Camera: Phoenix ICON (100° FOV); 1240x1240px; wide-field fundus photograph of an infant
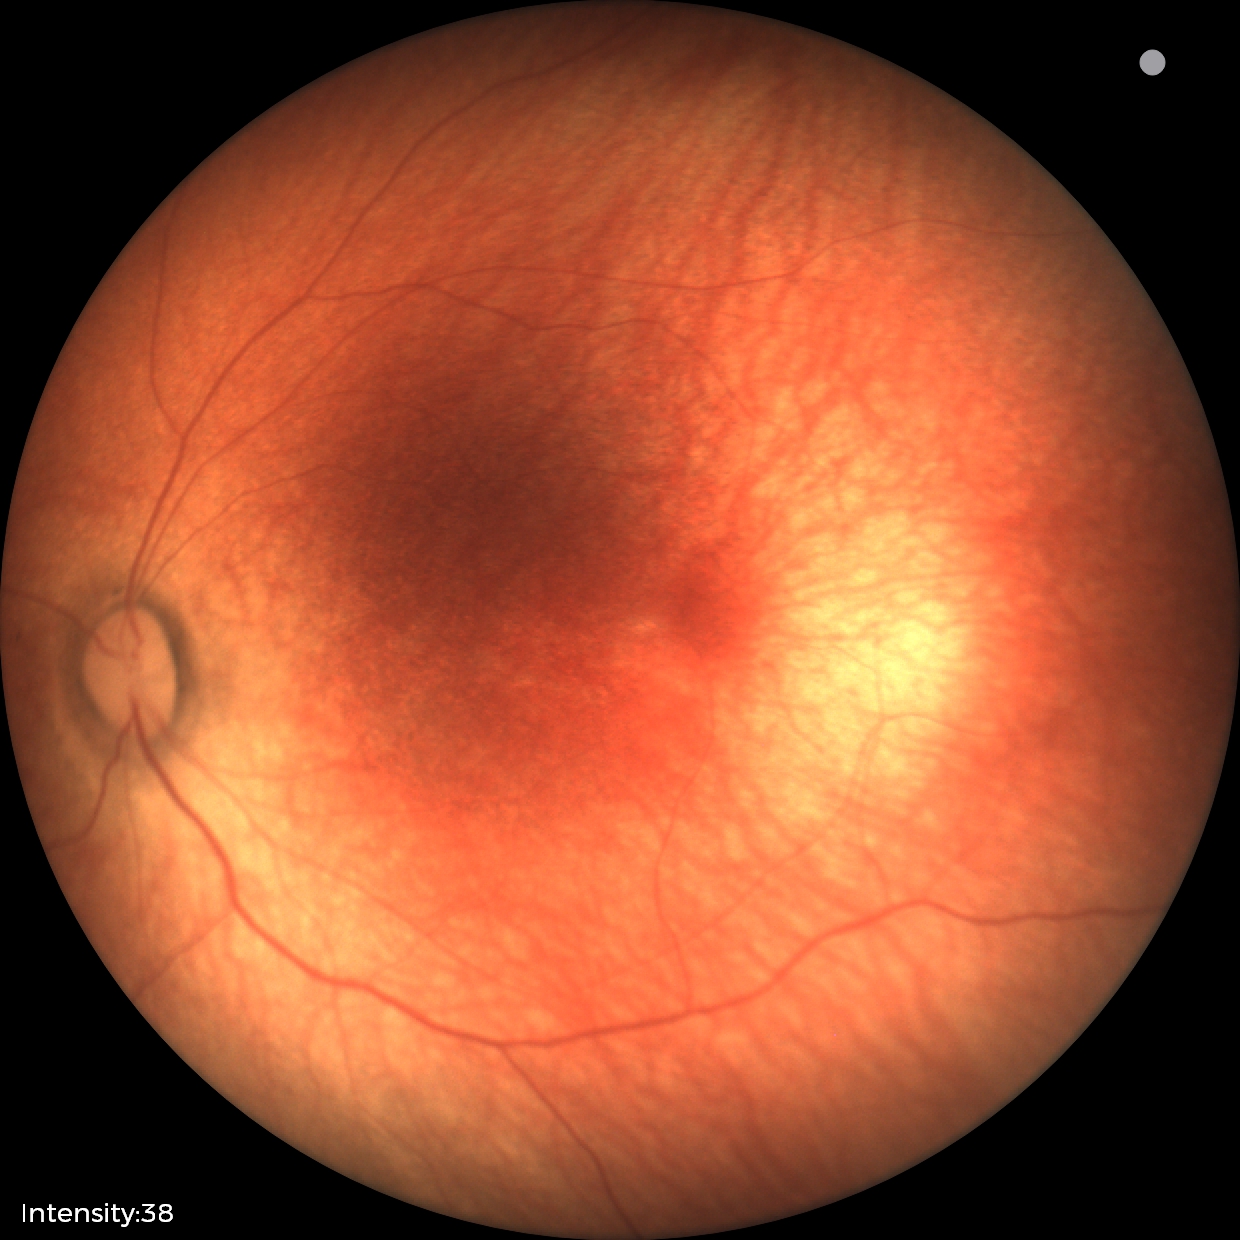
Finding = no pathology identified